Color fundus photograph. 848x848px. Modified Davis classification. FOV: 45 degrees. No pharmacologic dilation.
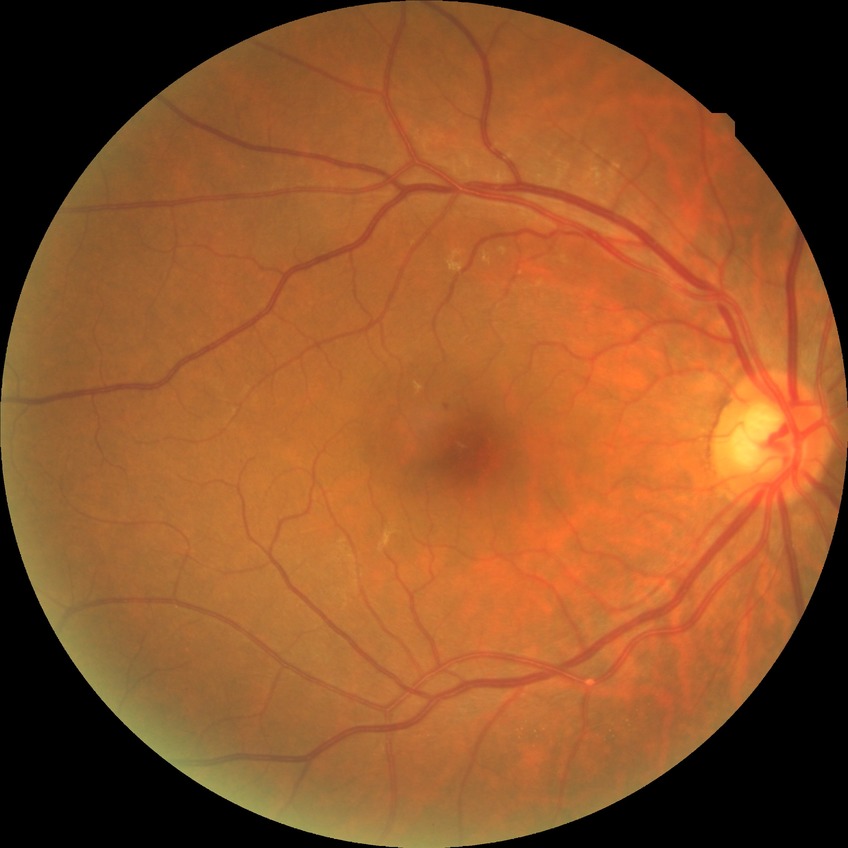

DR impression: negative for DR, Davis stage: NDR.